CFP: 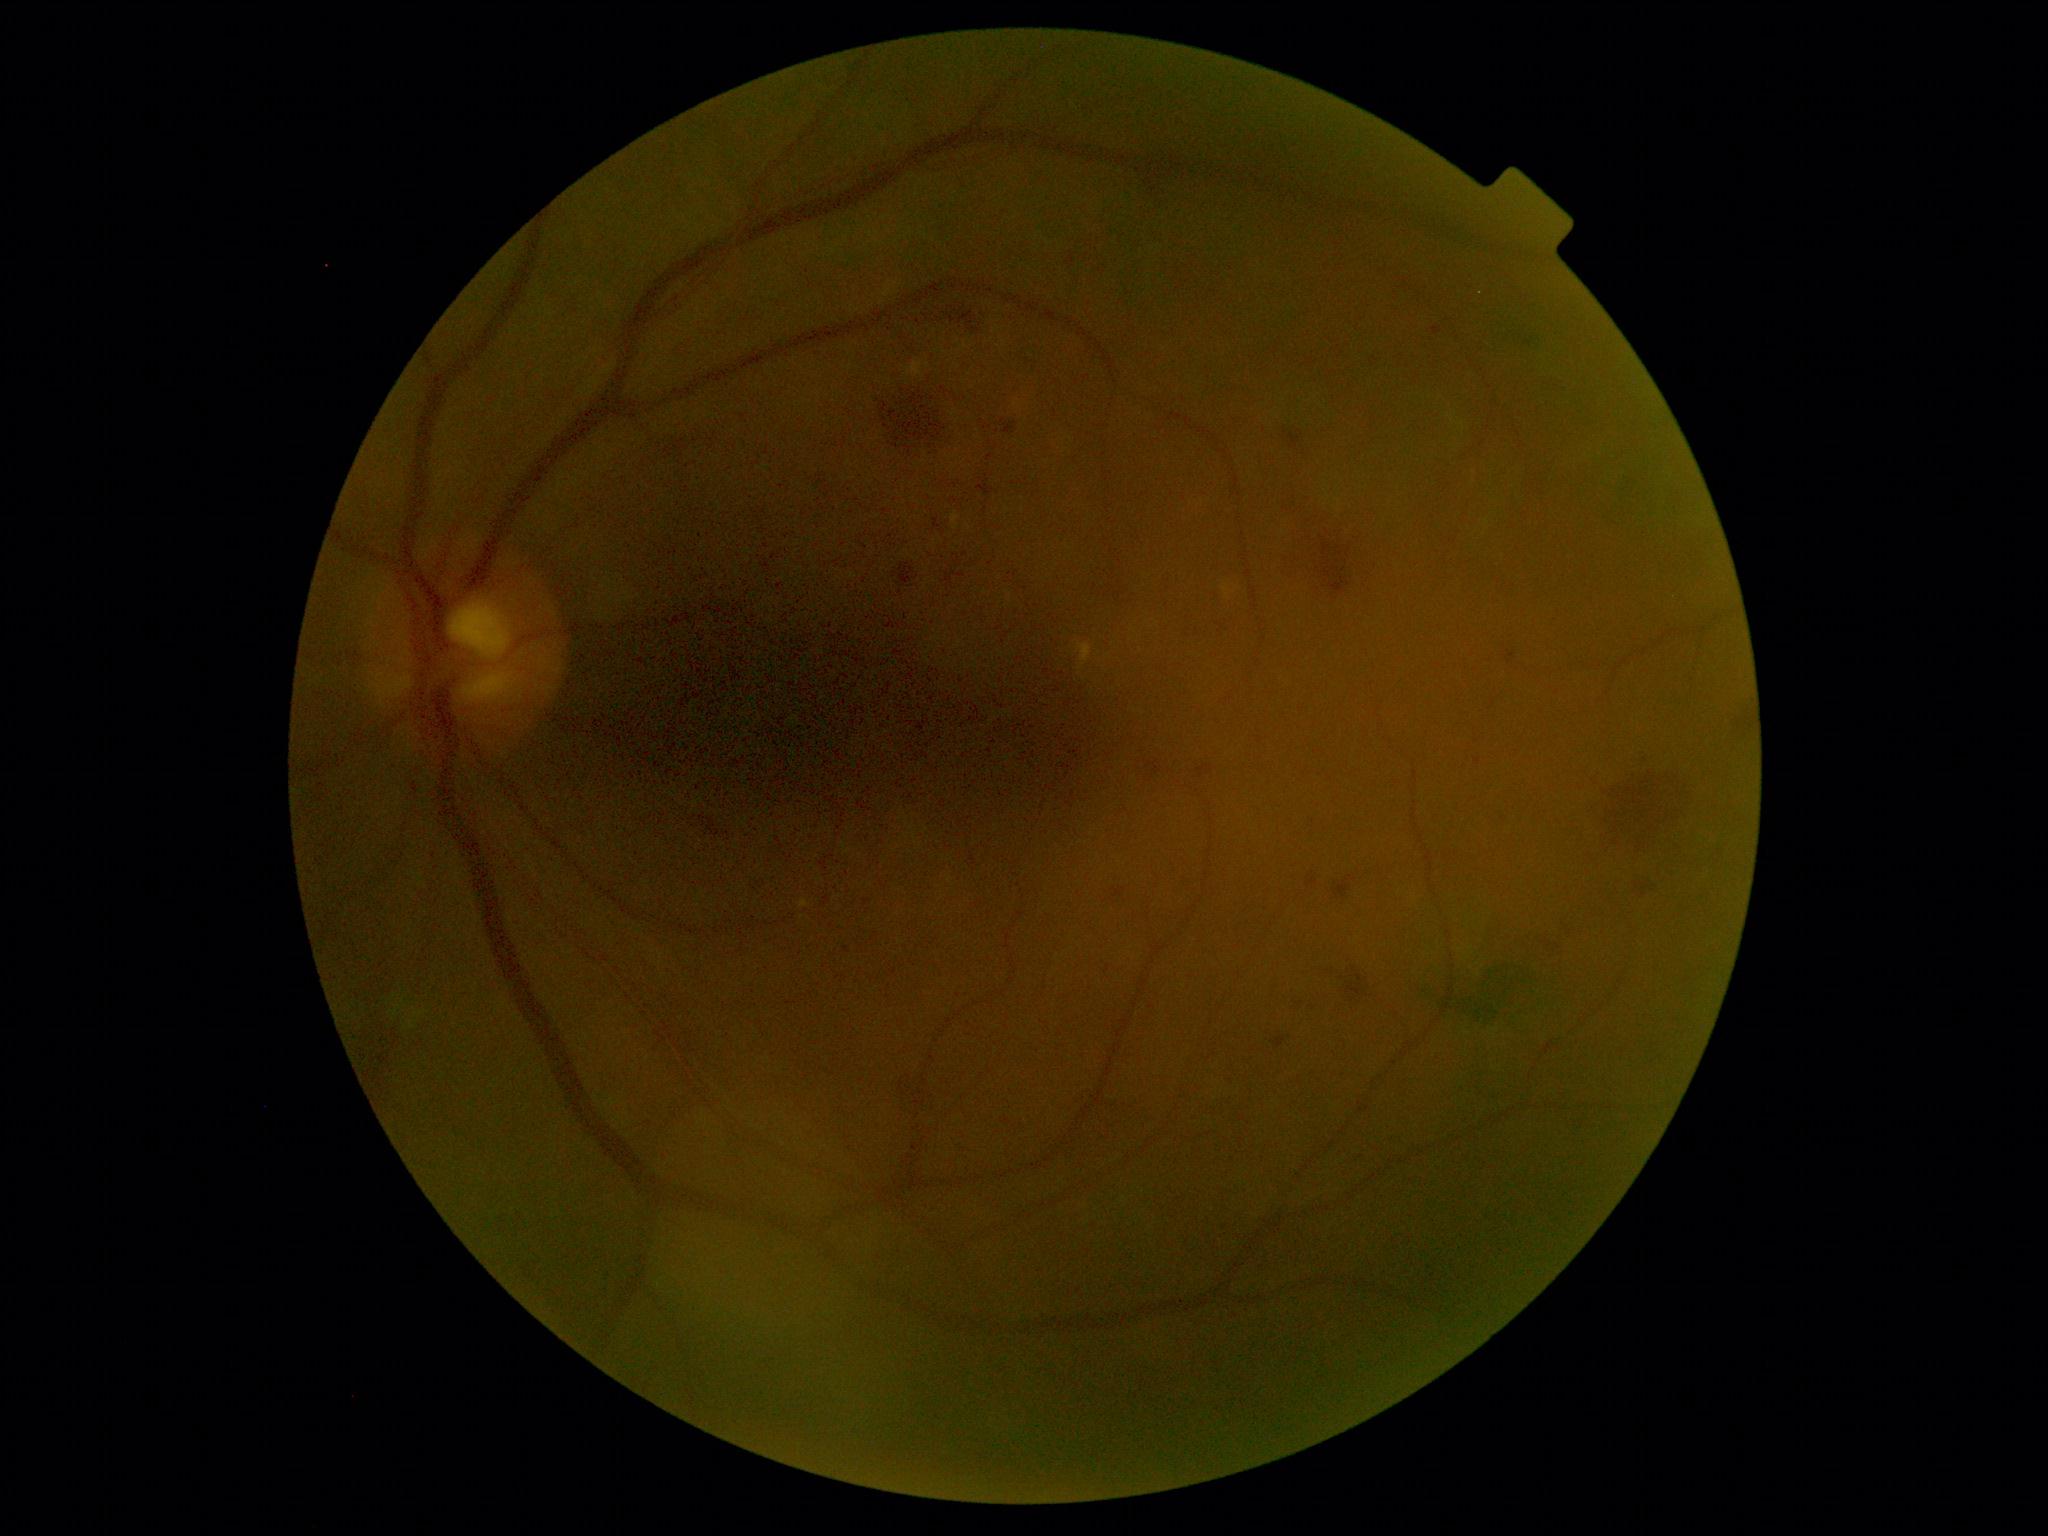
DR grade: 2 (moderate NPDR).